2352x1568
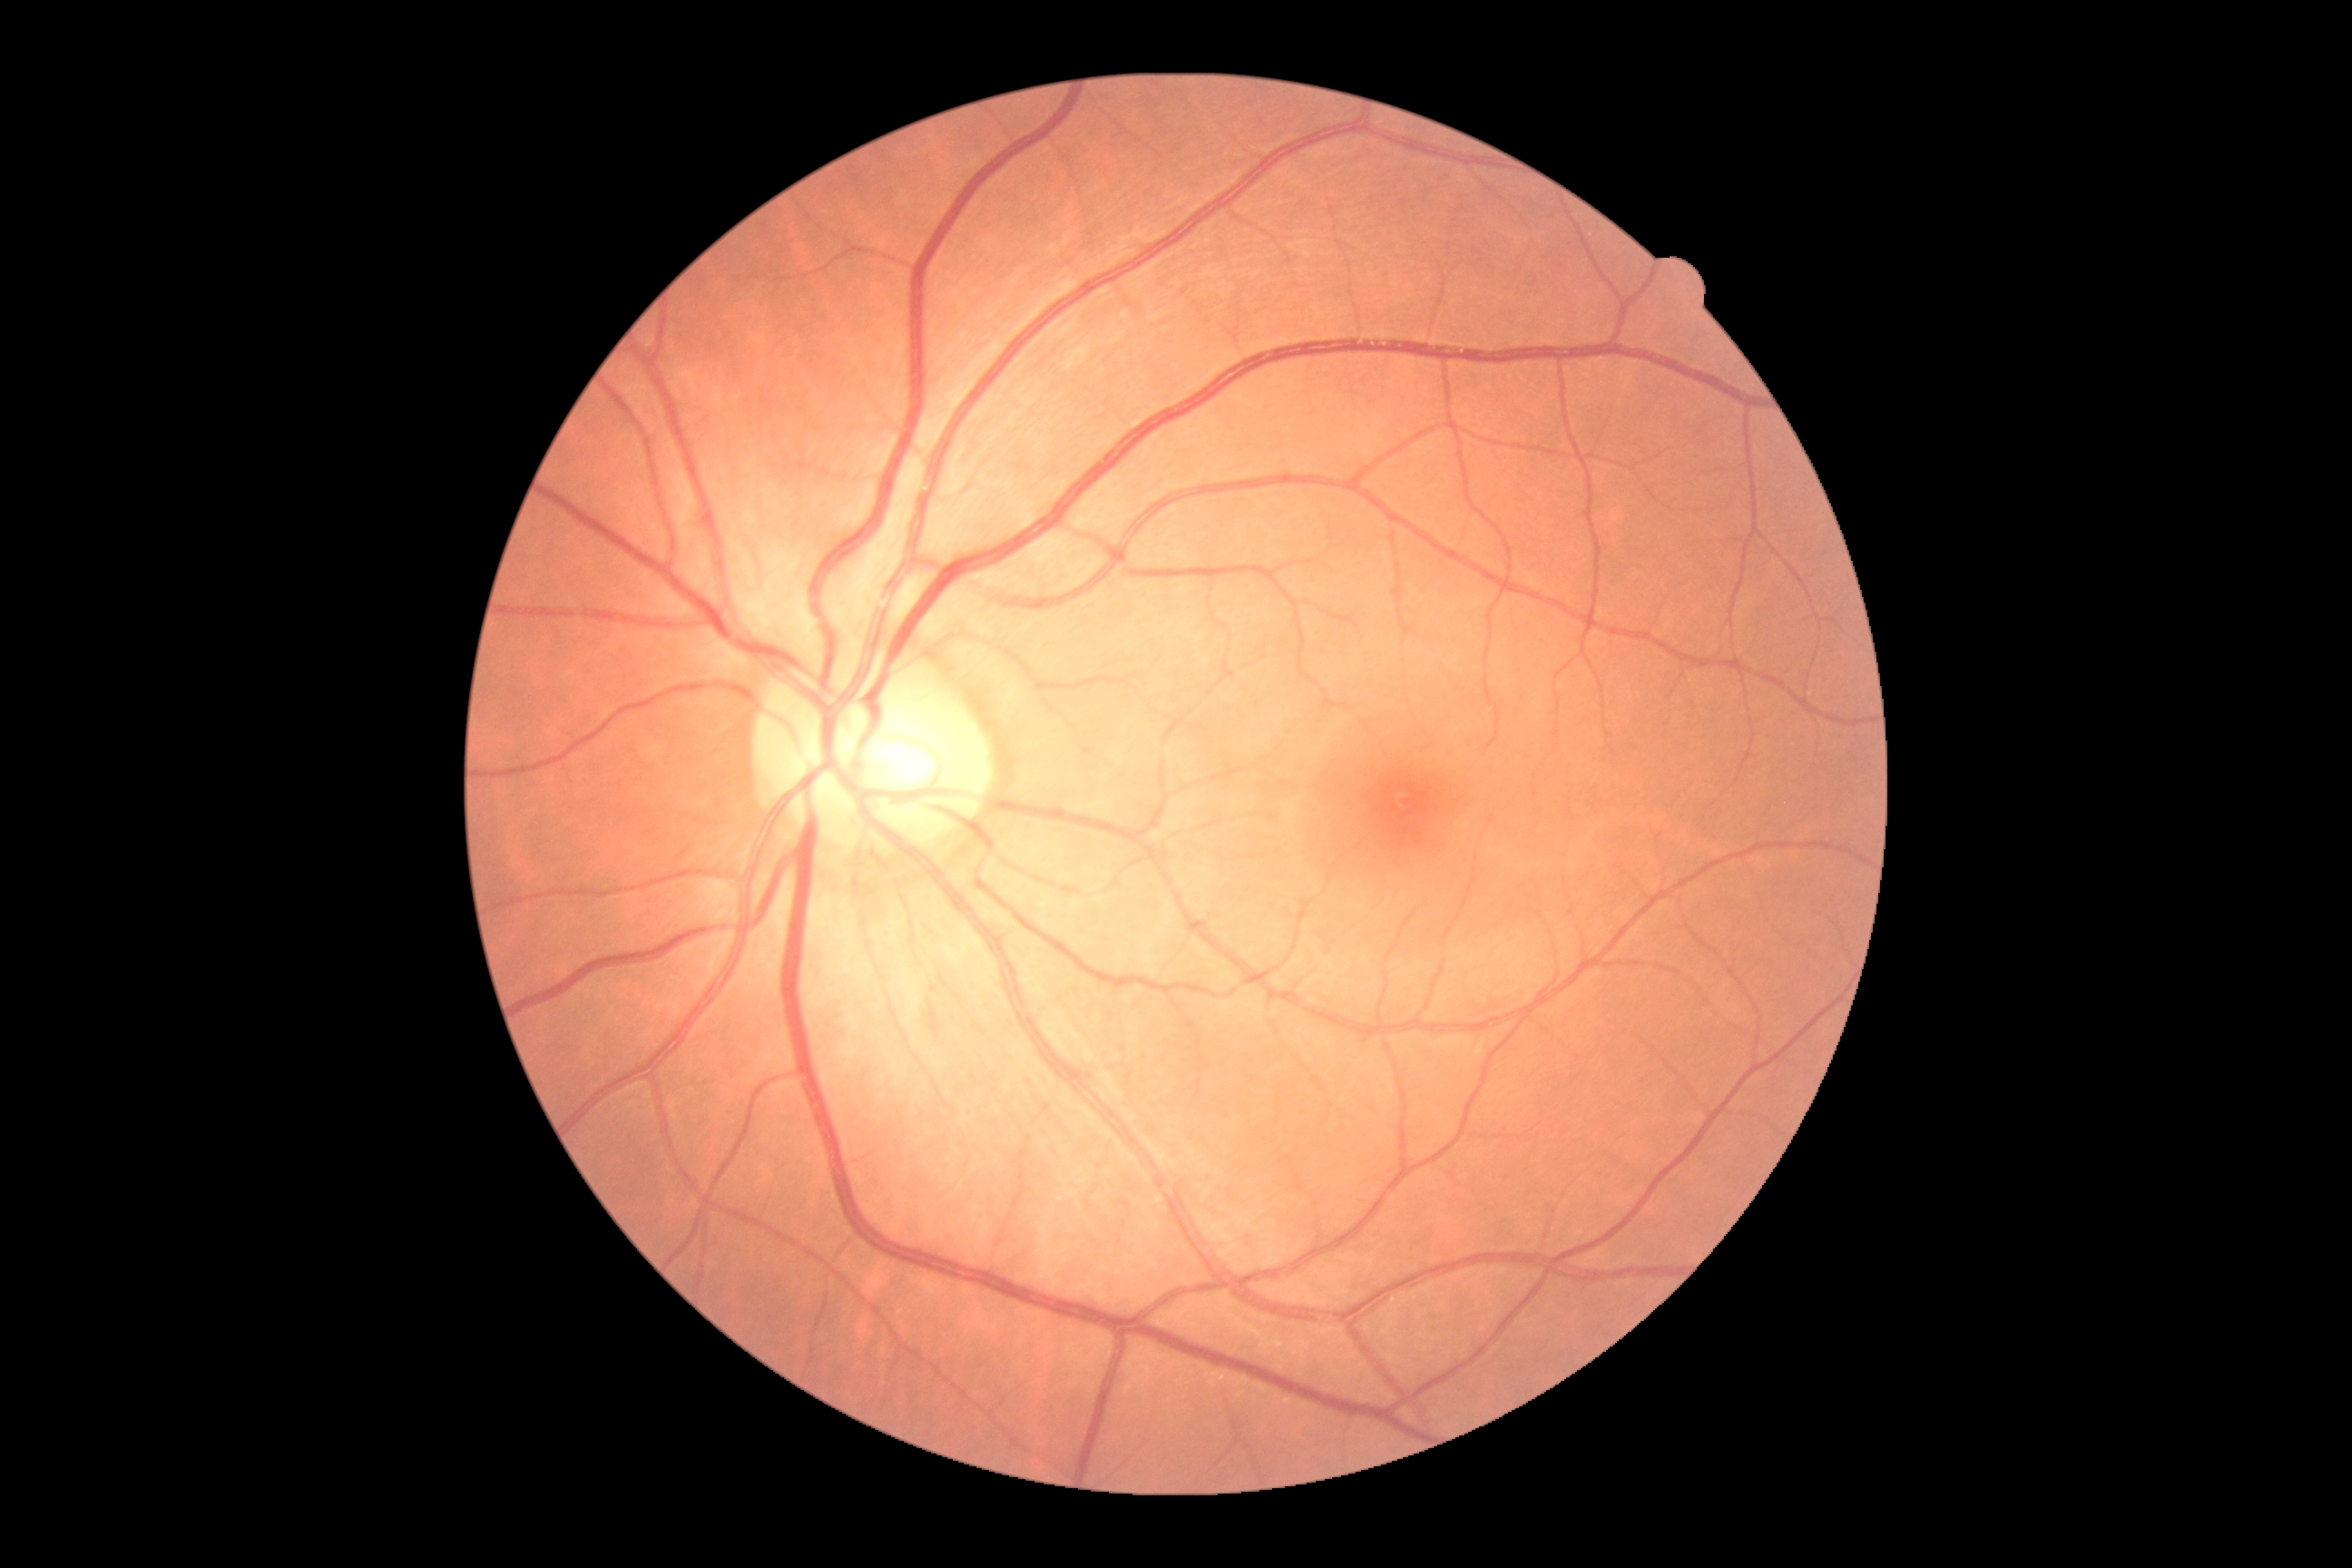 DR impression@no apparent DR, diabetic retinopathy@grade 0.